640 by 480 pixels · wide-field fundus photograph of an infant: 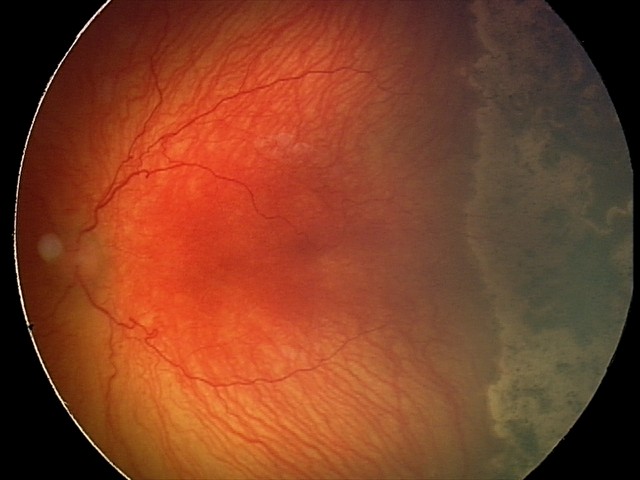
Series diagnosed as A-ROP (aggressive ROP). Plus disease present.